CFP:
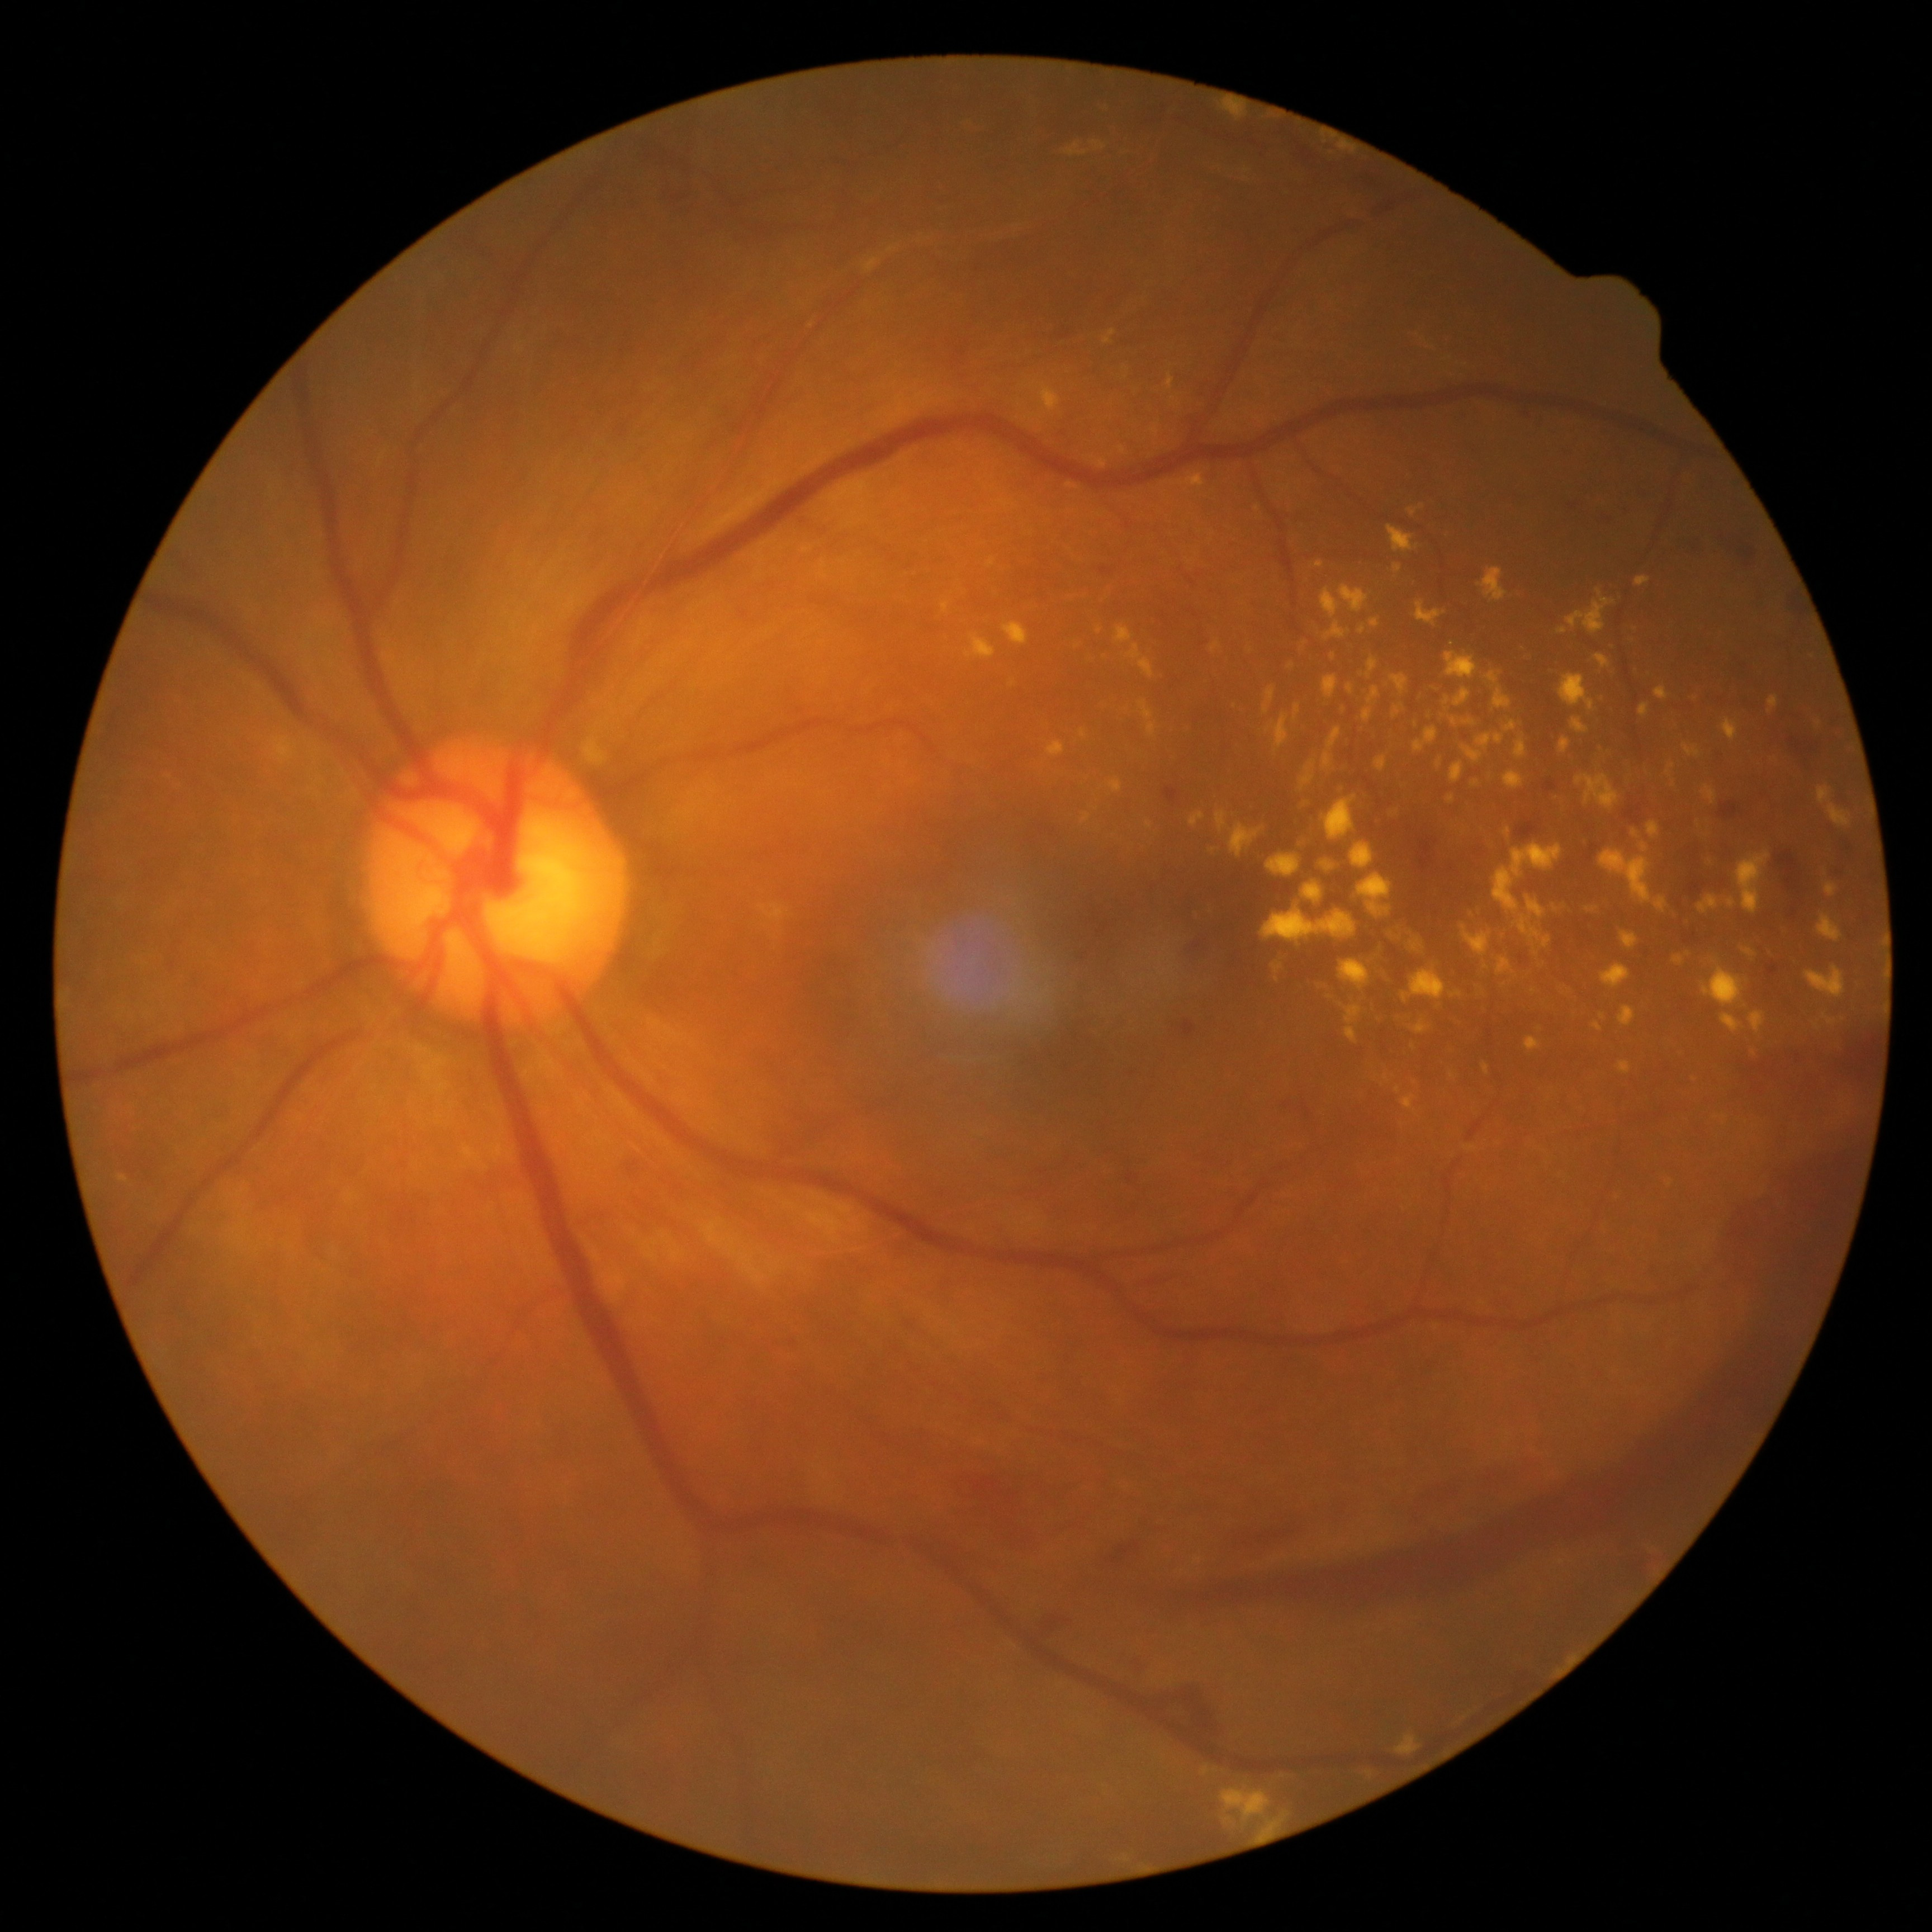

Diabetic retinopathy (DR): grade 4 (PDR) — neovascularization and/or vitreous/pre-retinal hemorrhage
Selected lesions:
* hard exudates (EXs) (continued): bbox(1324, 621, 1351, 641) | bbox(1359, 875, 1391, 916) | bbox(1649, 821, 1661, 839) | bbox(1298, 792, 1312, 816) | bbox(1224, 101, 1245, 120) | bbox(1620, 1006, 1635, 1026) | bbox(942, 602, 950, 614) | bbox(1625, 627, 1643, 676) | bbox(1504, 828, 1511, 839) | bbox(1666, 763, 1675, 776) | bbox(1401, 1094, 1416, 1112) | bbox(1504, 721, 1517, 733) | bbox(1315, 561, 1324, 567) | bbox(1736, 851, 1770, 914) | bbox(1549, 977, 1576, 1005) | bbox(1413, 1022, 1428, 1035)
* Small EXs approximately at (x=1397, y=1090) | (x=1100, y=630) | (x=1033, y=416)